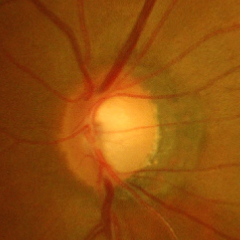

Glaucoma status: advanced-stage glaucoma. (Criteria: near-total cupping of the optic nerve head, with or without severe visual field loss within the central 10 degrees of fixation.)